Fundus photo: 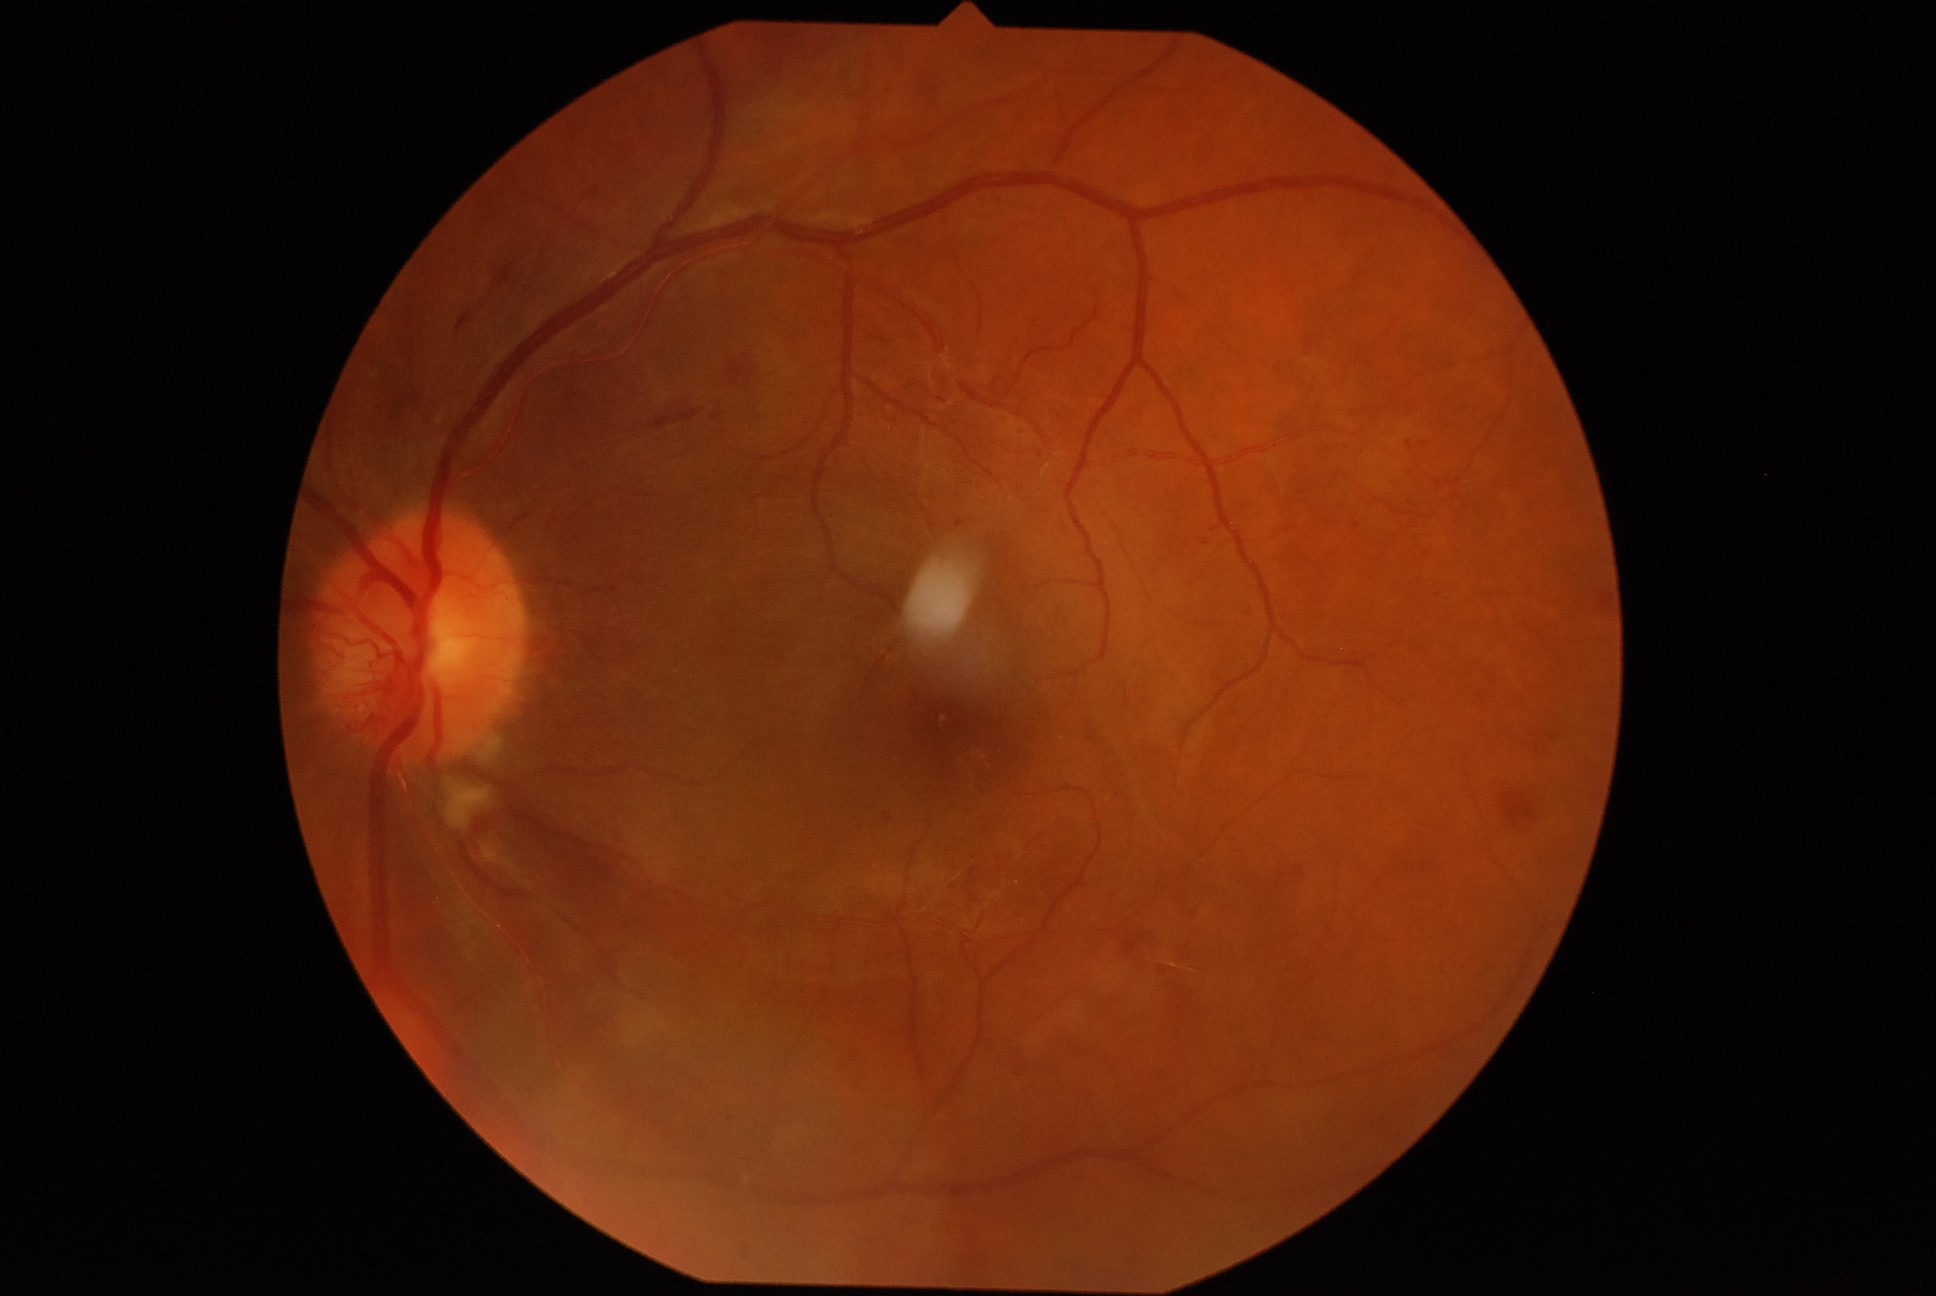
DR grade is moderate NPDR (2).